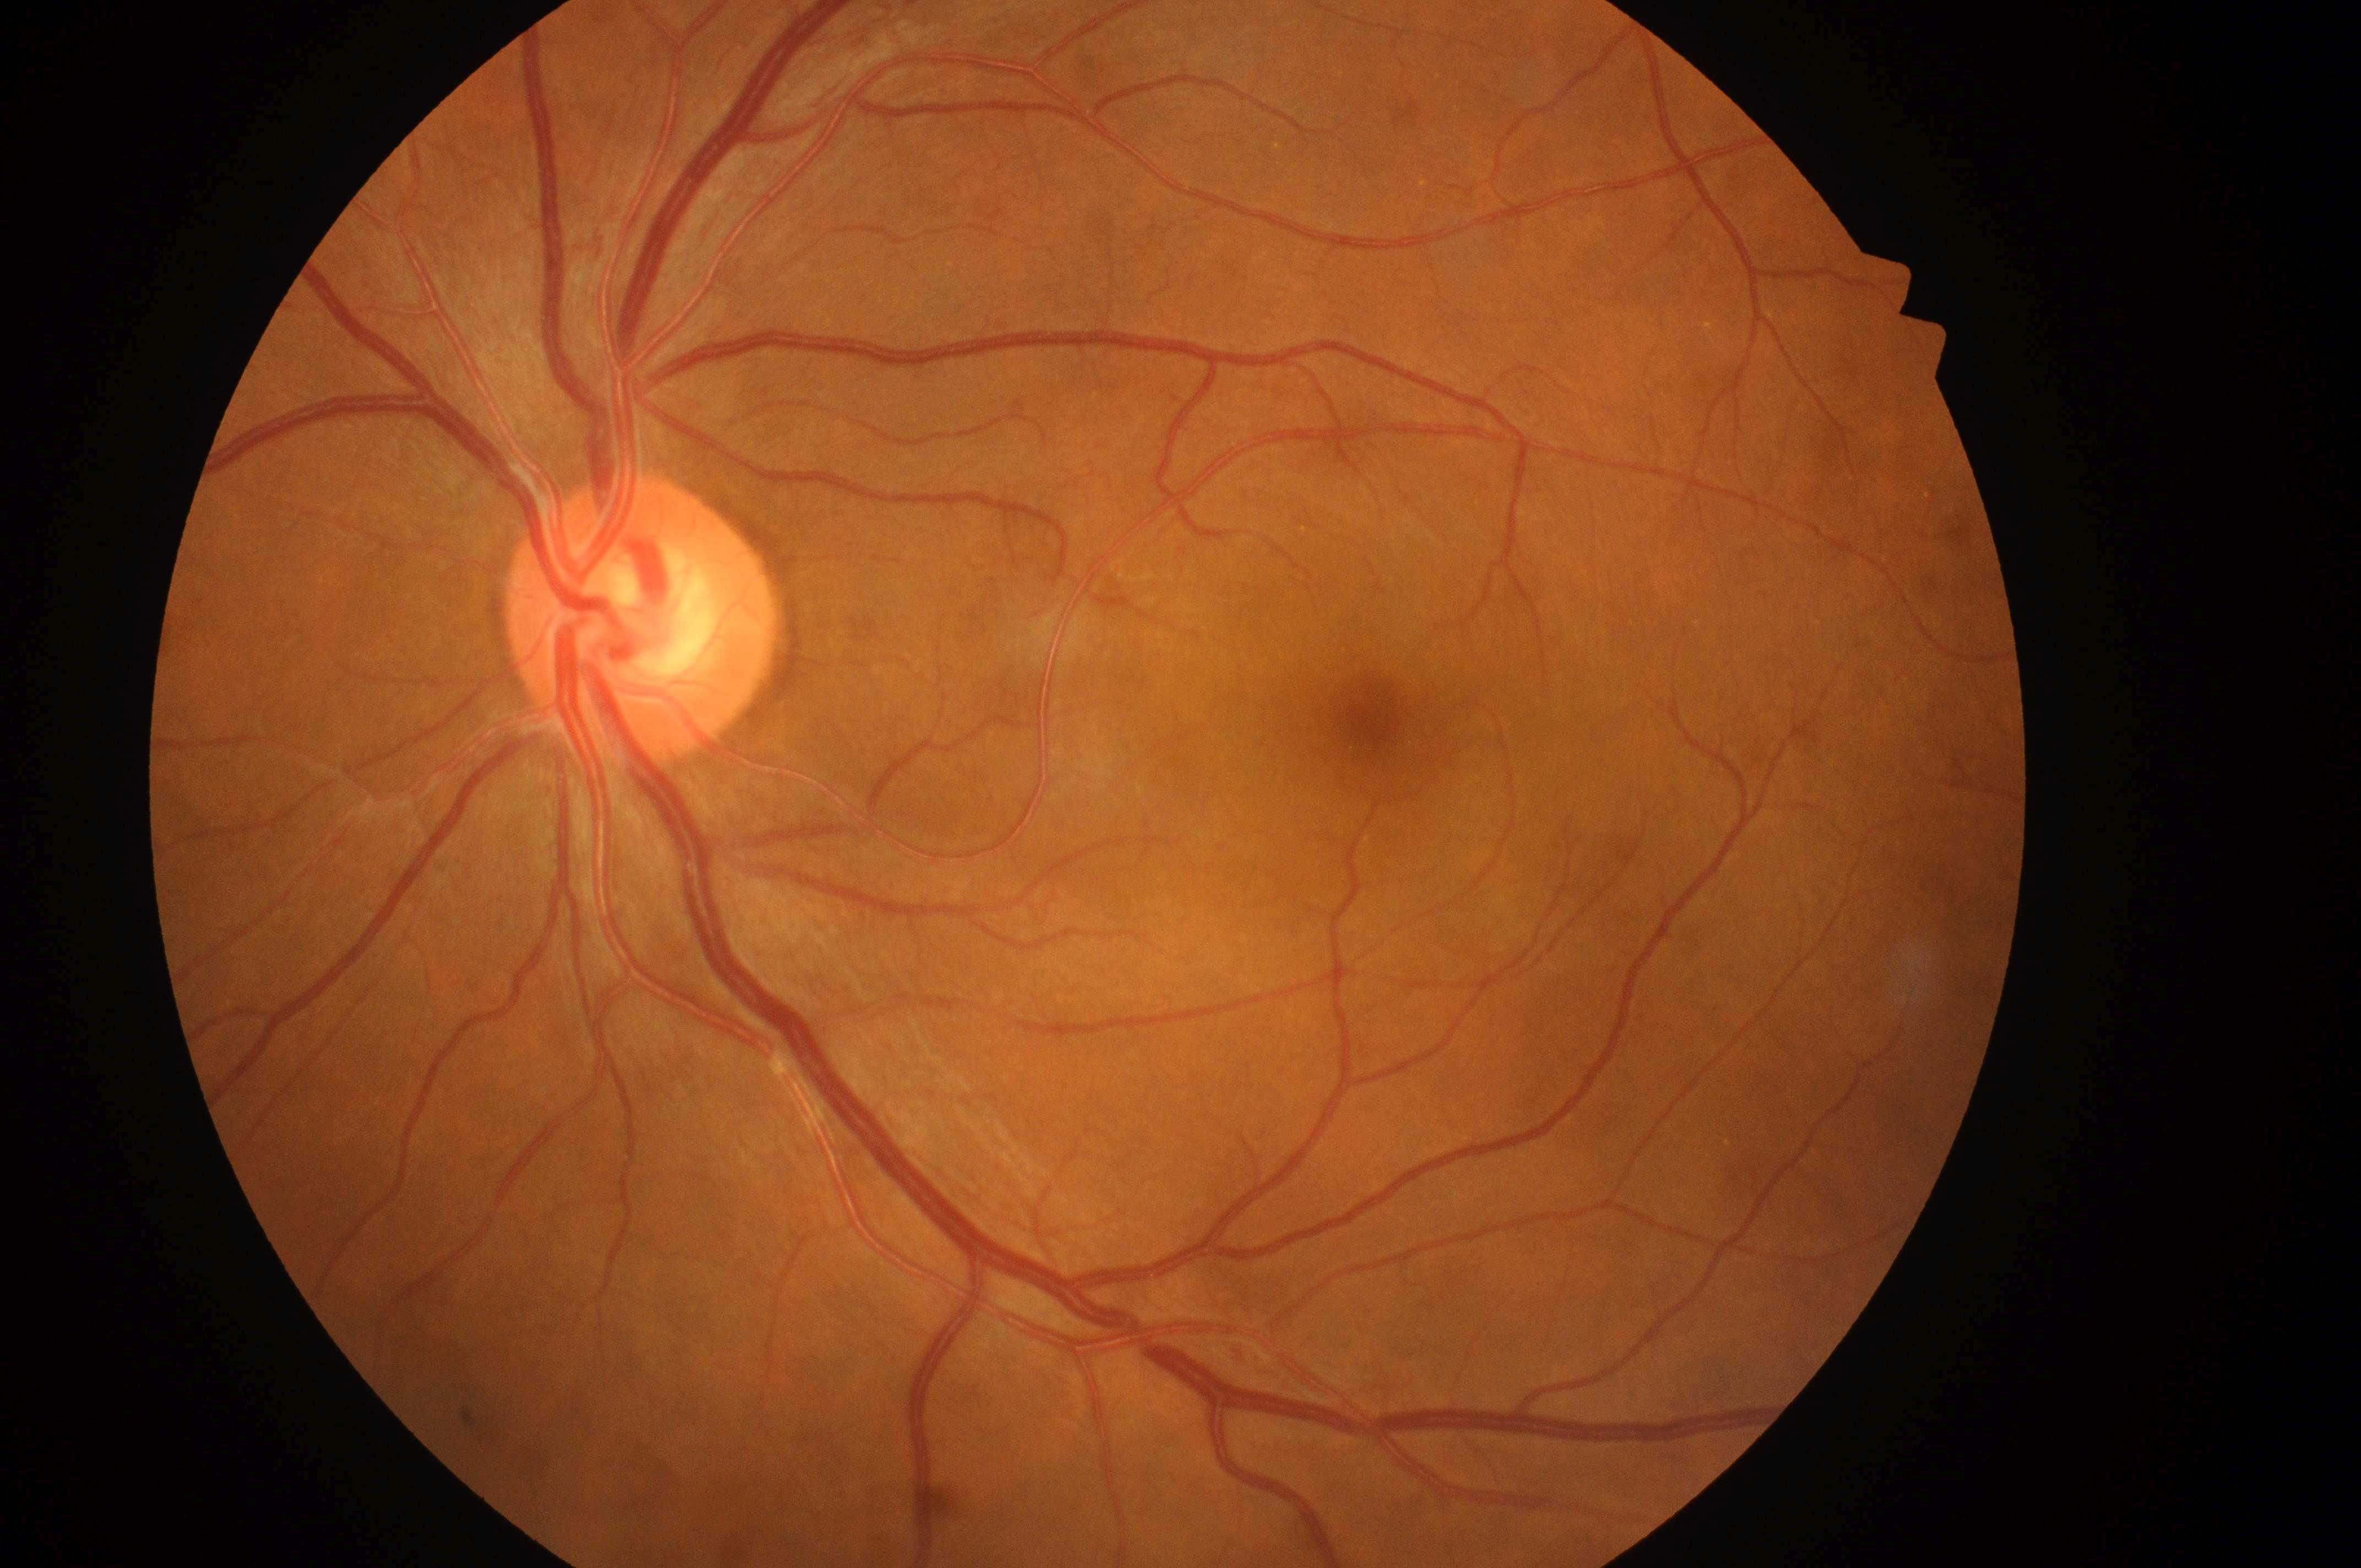
- DR class: non-proliferative diabetic retinopathy
- diabetic retinopathy (DR): grade 3 (severe NPDR)
- laterality: left
- foveal center: [1372, 719]
- optic nerve head: [635, 629]
- diabetic macular edema (DME): grade 0 (no risk)